2048 by 1536 pixels · 45-degree field of view
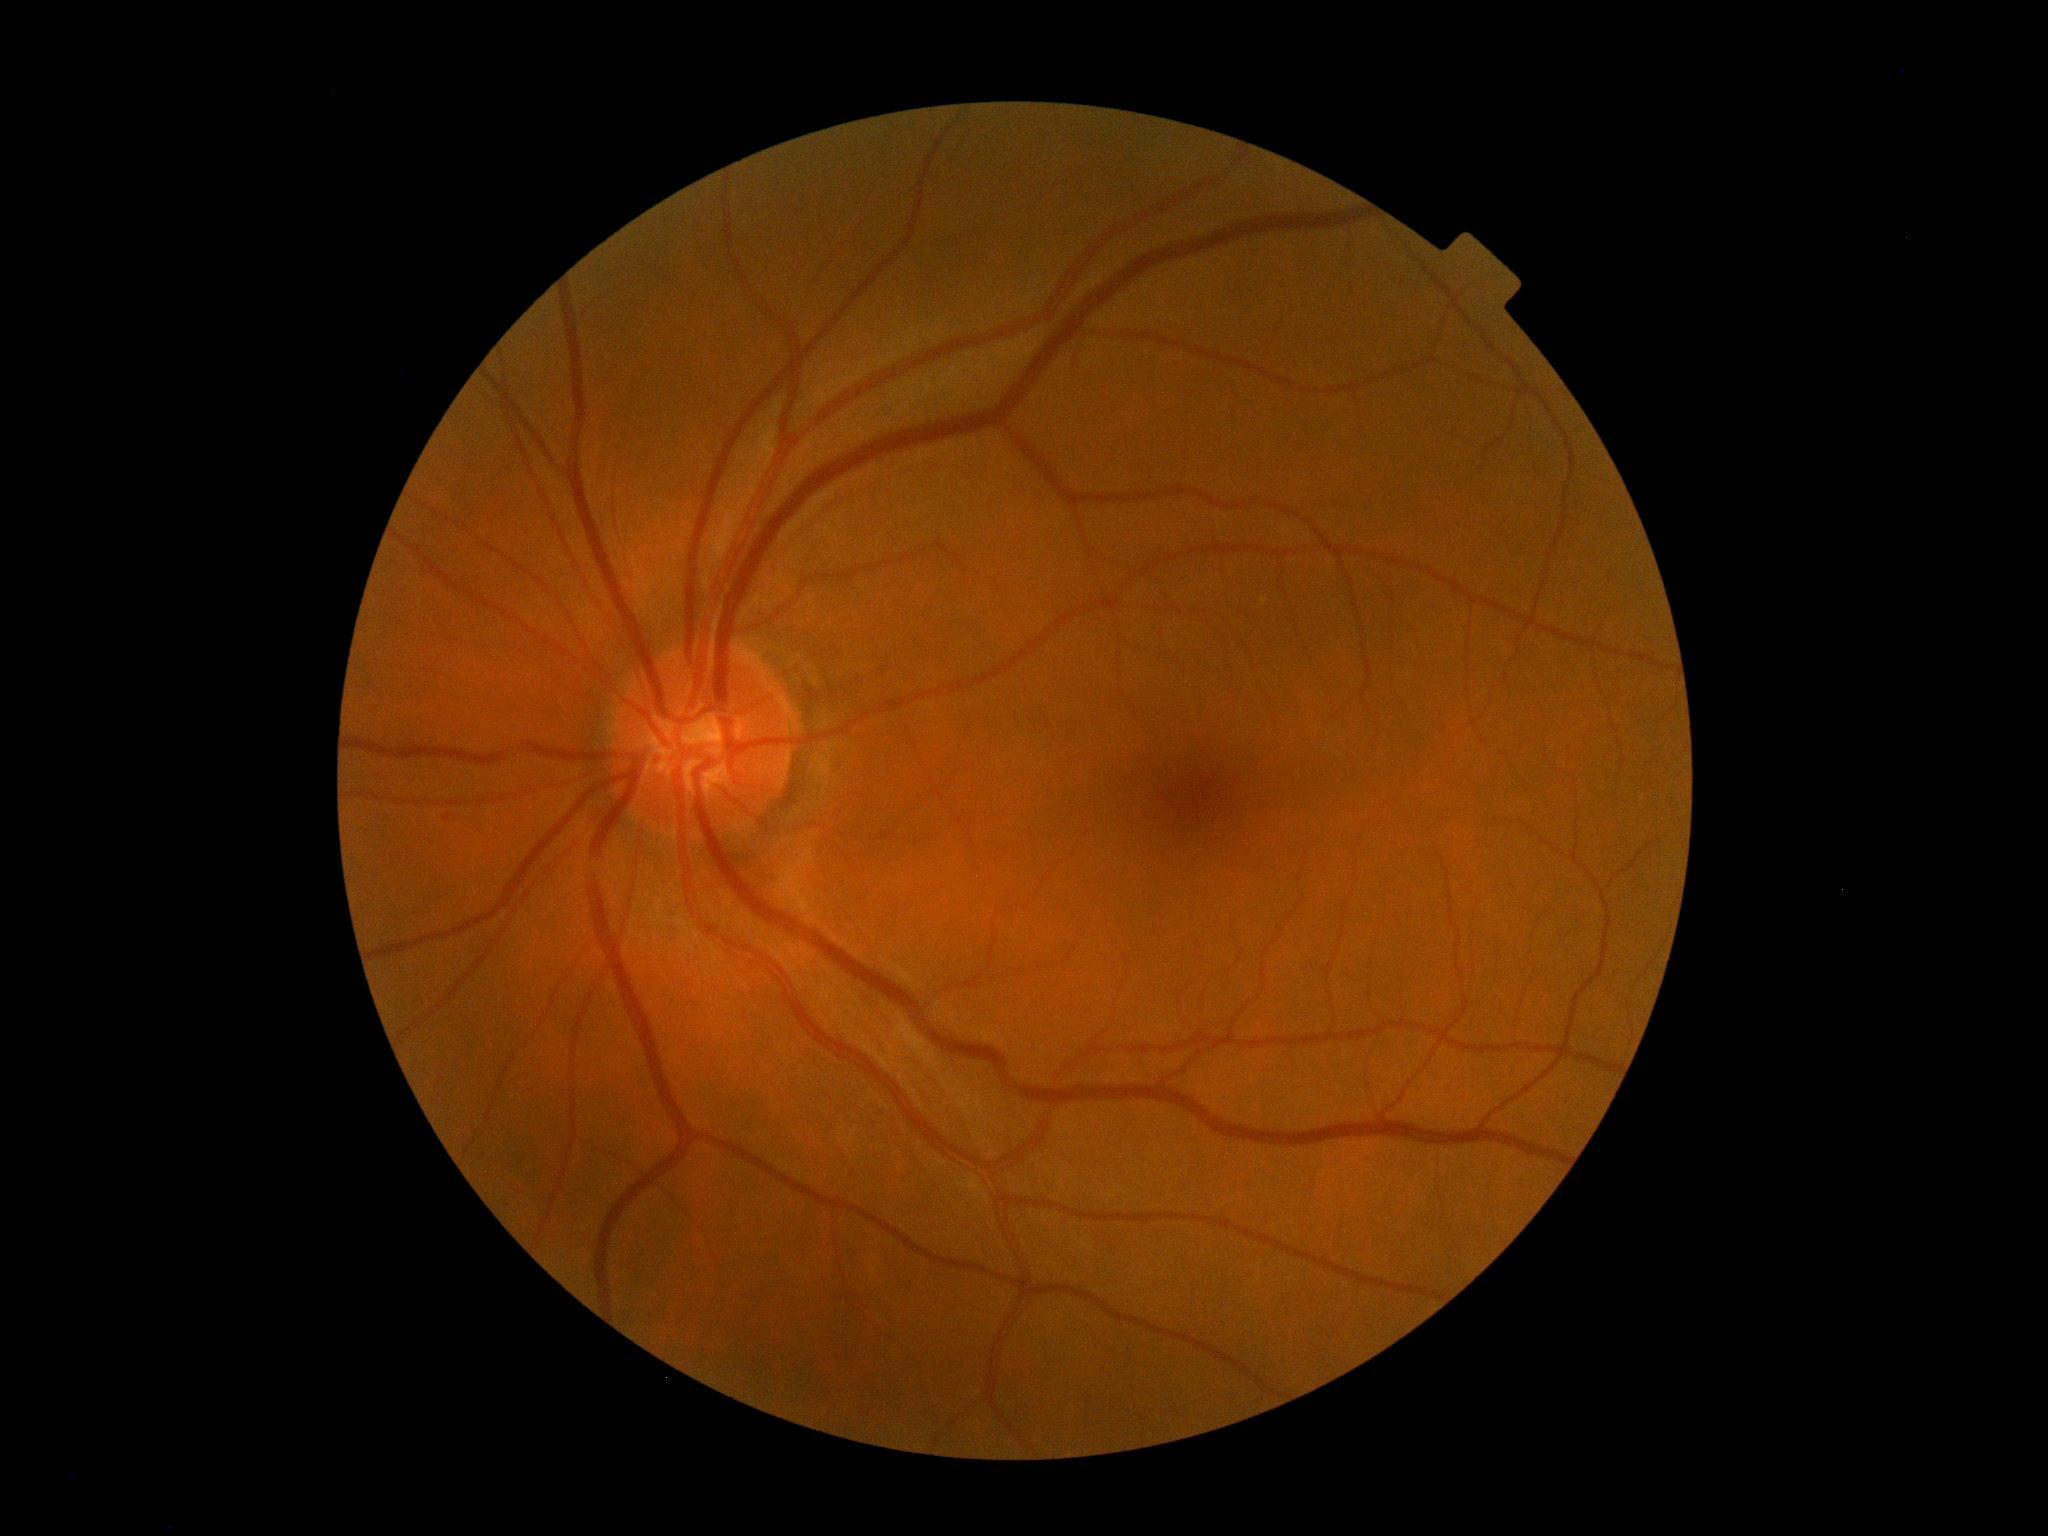 DR impression = no signs of DR; diabetic retinopathy (DR) = 0.